Infant wide-field retinal image:
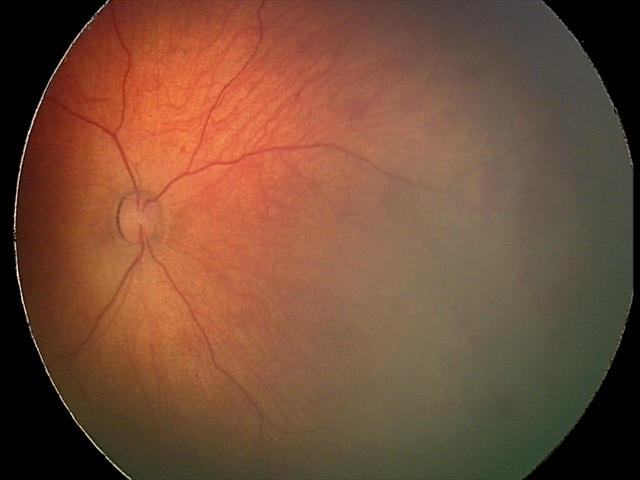
Screening diagnosis: retinal hemorrhages.